Image size 2352x1568 · color fundus photograph: 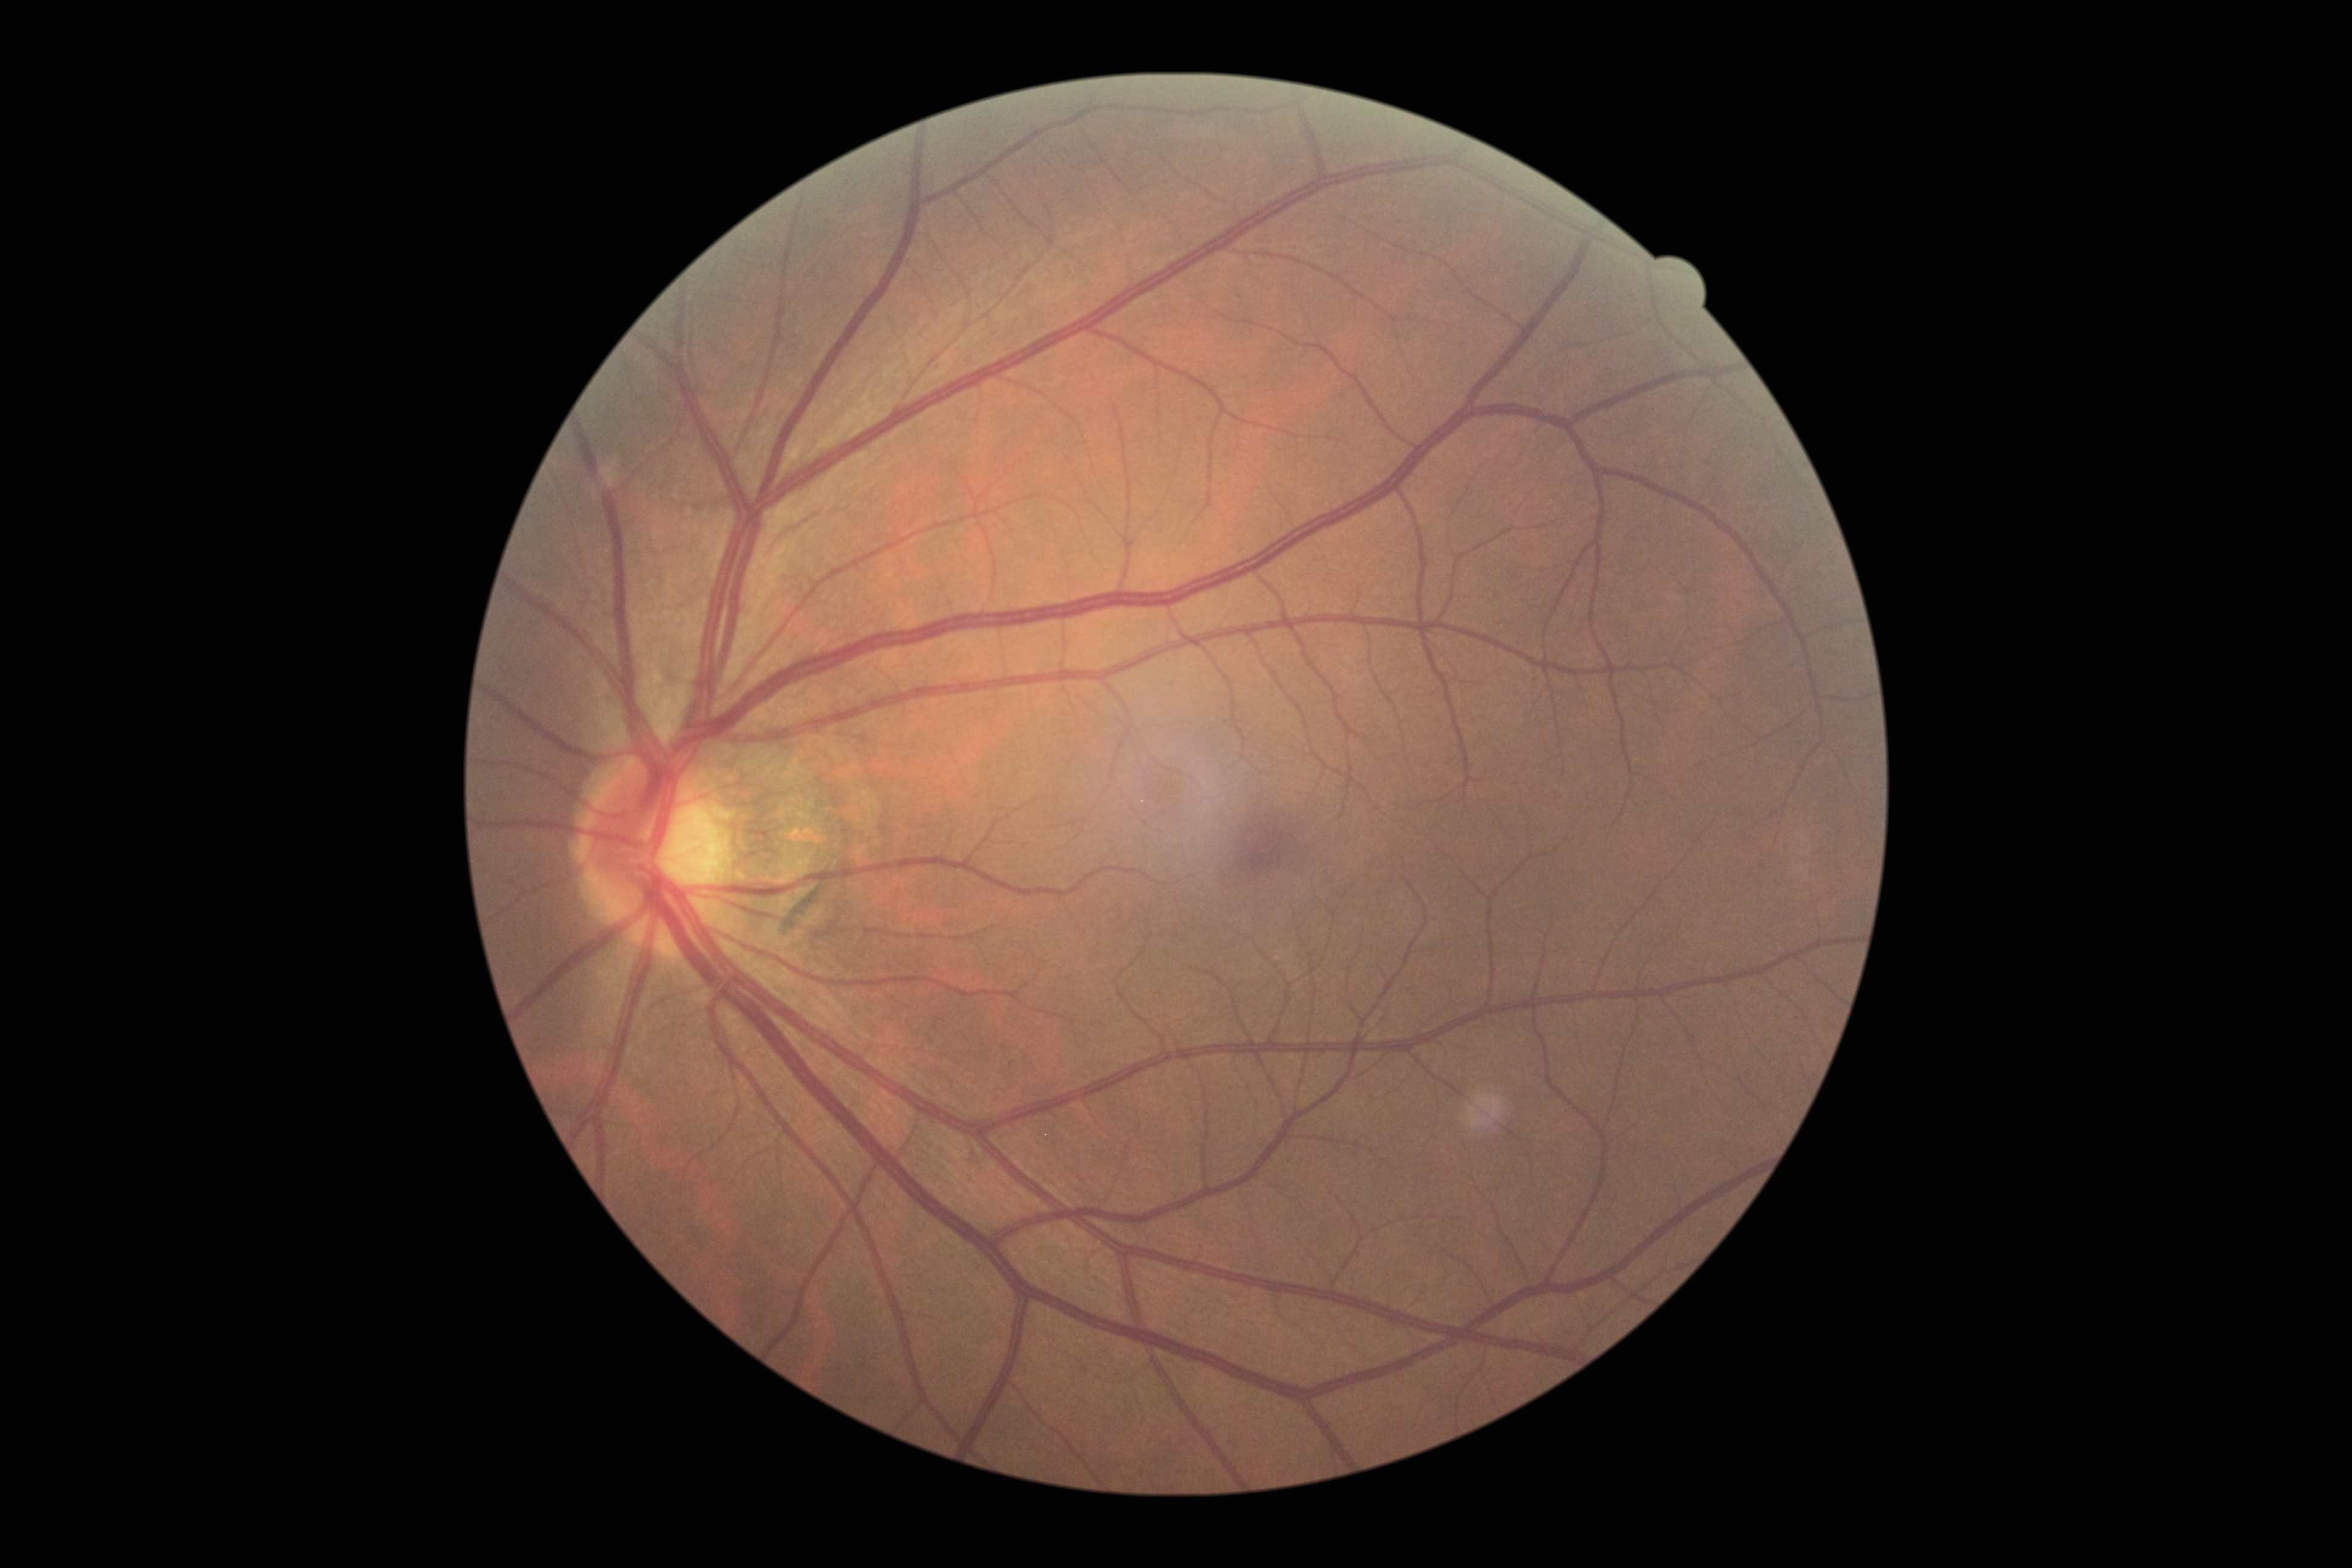
Diabetic retinopathy (DR) is no apparent diabetic retinopathy (grade 0) — no visible signs of diabetic retinopathy.